Image size 2361x1568 · pupil-dilated · fundus photo · 50-degree field of view:
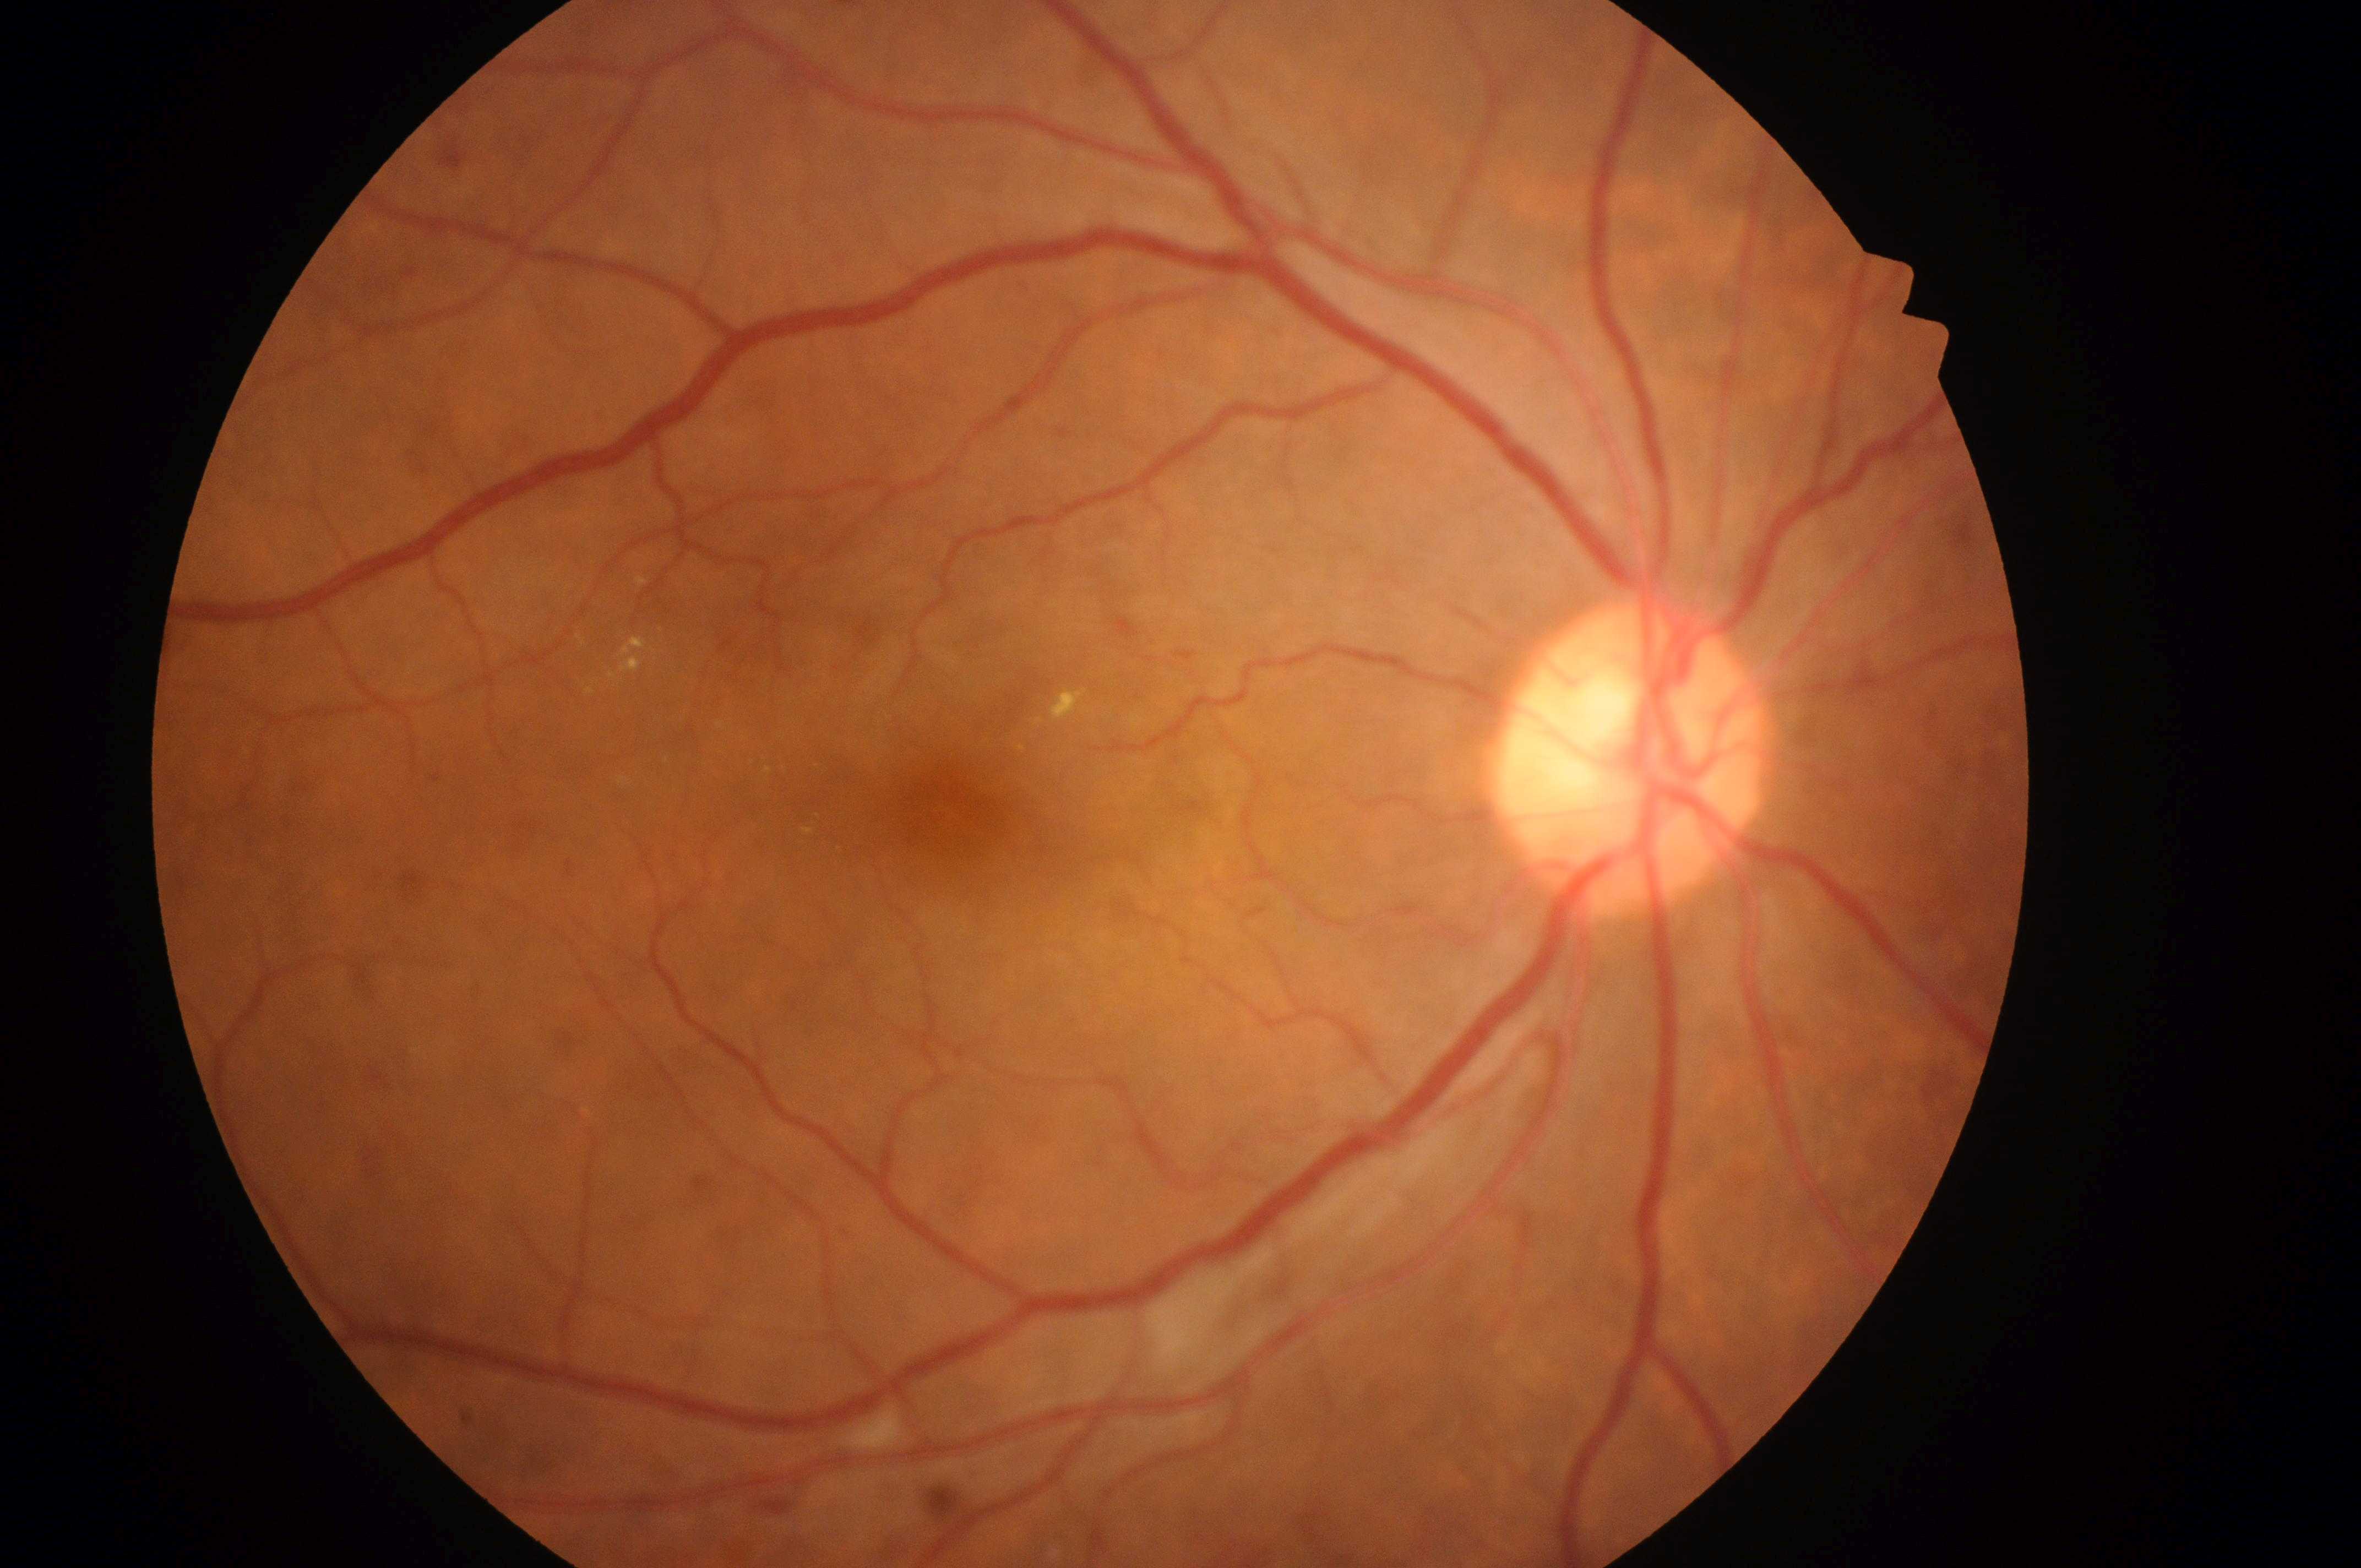 Q: What is the DR grade?
A: 2 (moderate NPDR)
Q: What is the DME risk grade?
A: high risk (grade 2)
Q: Which eye is imaged?
A: OD
Q: Where is the optic disc?
A: (x=1623, y=773)
Q: Locate the fovea.
A: (x=961, y=823)